Modified Davis grading:
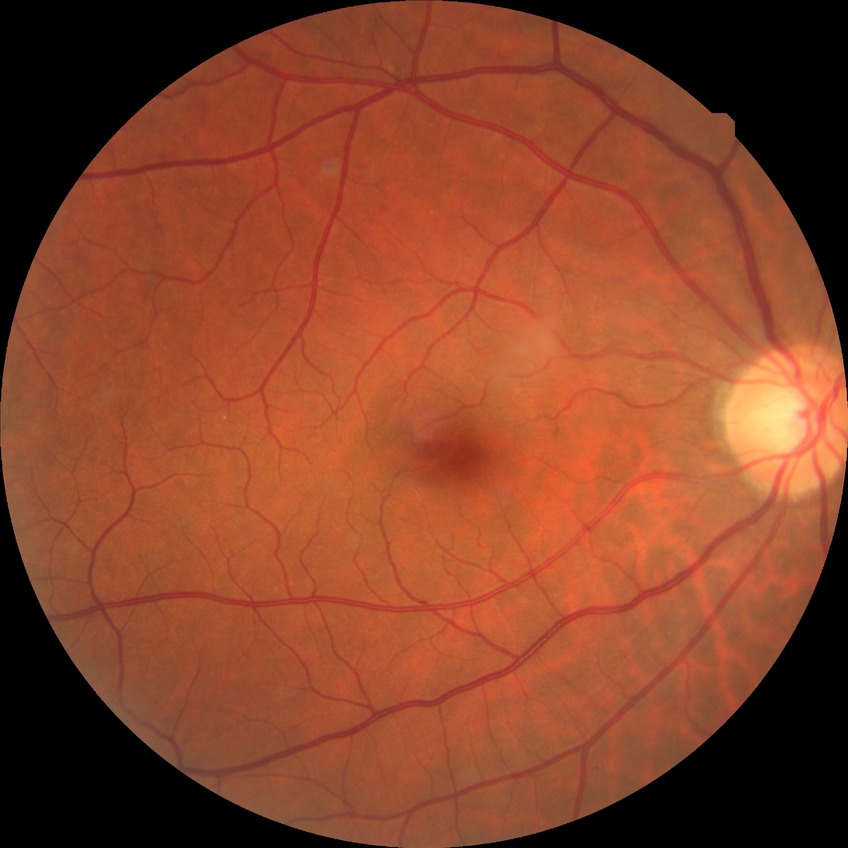
– diabetic retinopathy (DR): NDR (no diabetic retinopathy)